Acquired with a NIDEK AFC-230, CFP:
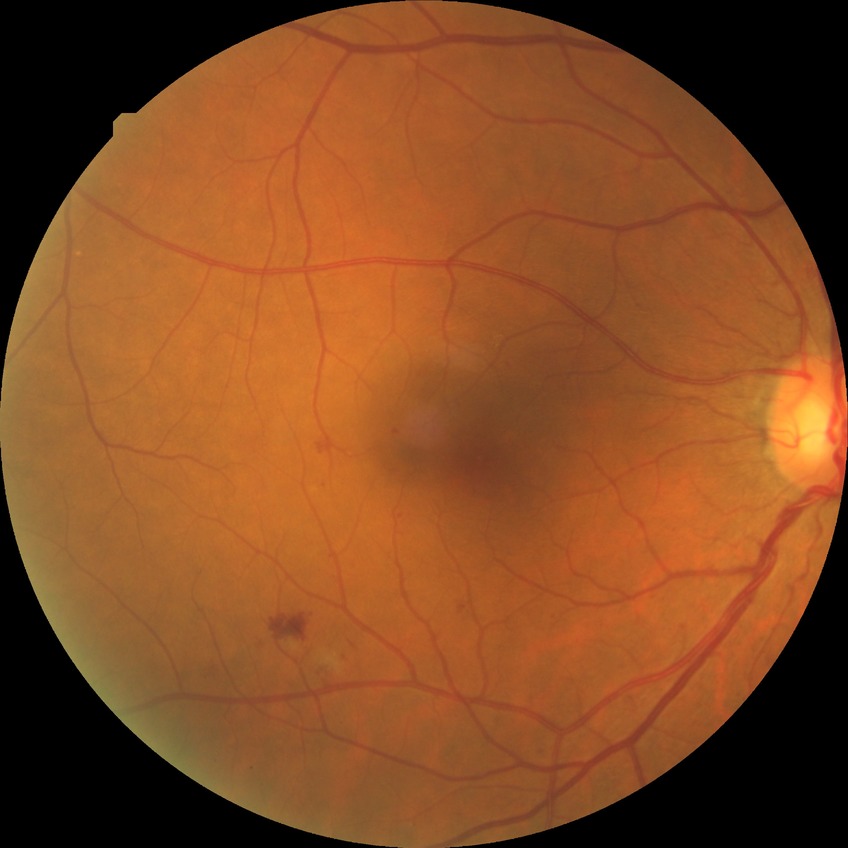
Diabetic retinopathy (DR) is SDR (simple diabetic retinopathy).